Non-mydriatic fundus camera; Nidek AFC-330.
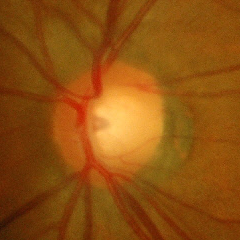
Showing early glaucoma.